2352x1568px. 45° FOV: 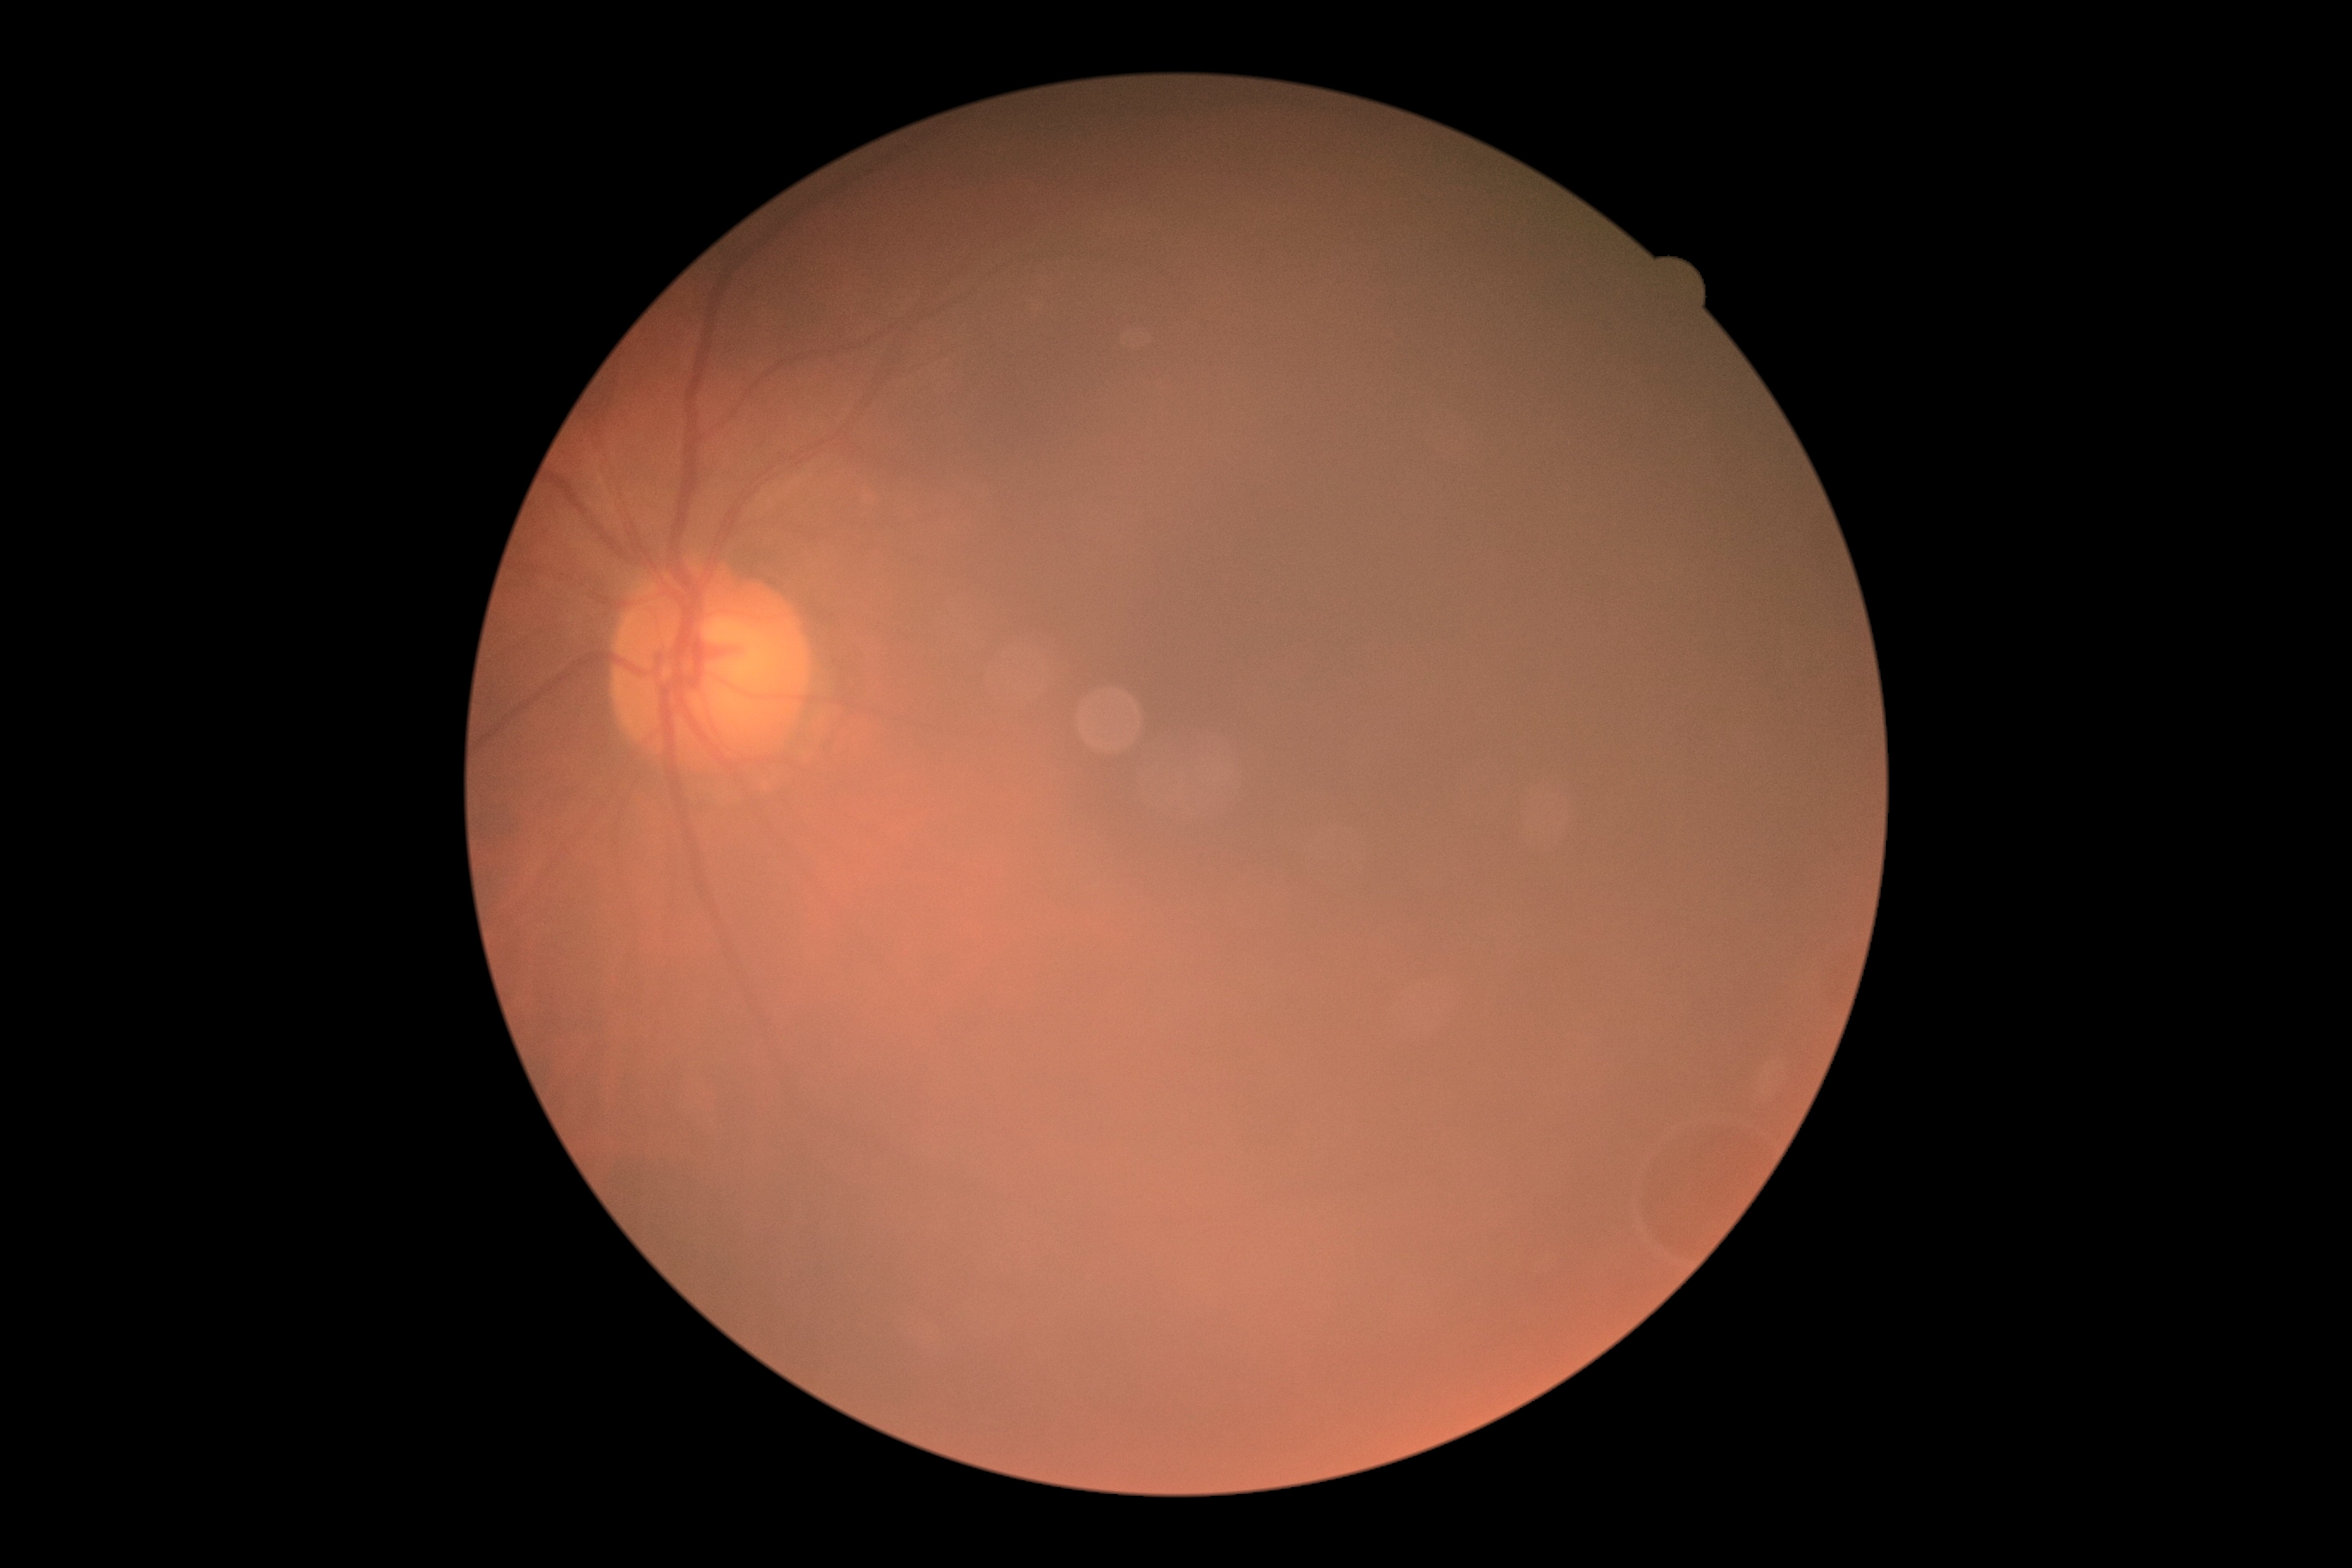

diabetic retinopathy (DR)=ungradable.